640x480 · wide-field fundus photograph of an infant · Clarity RetCam 3, 130° FOV — 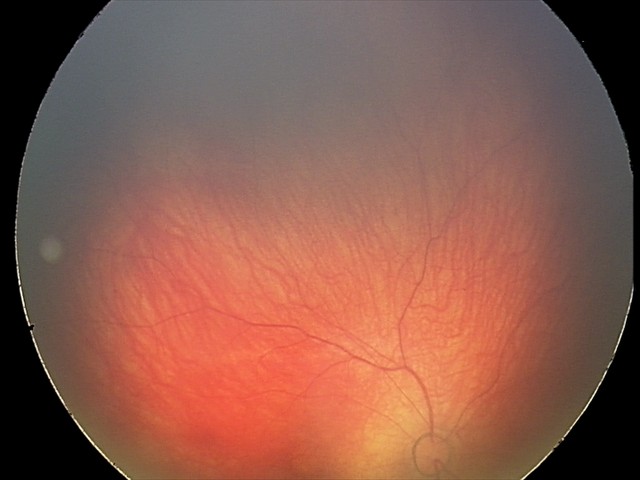 Impression: retinal hemorrhages.